Wide-field fundus photograph of an infant — 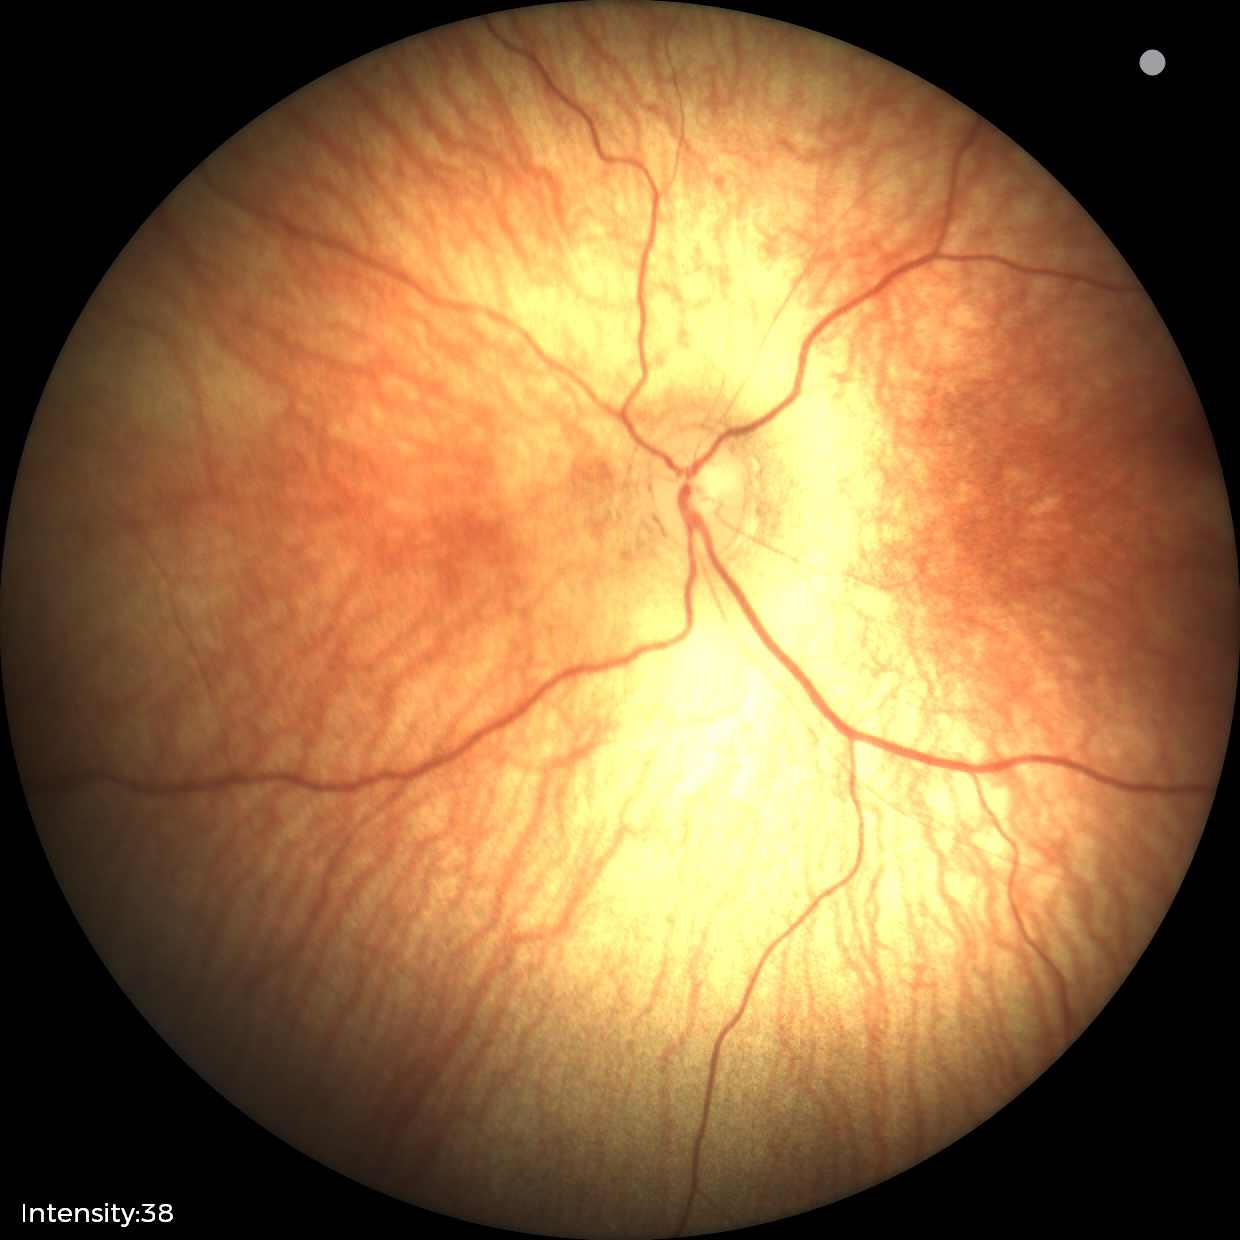
Screening diagnosis = physiological appearance.